Camera: Remidio Fundus on Phone (FOP) camera.
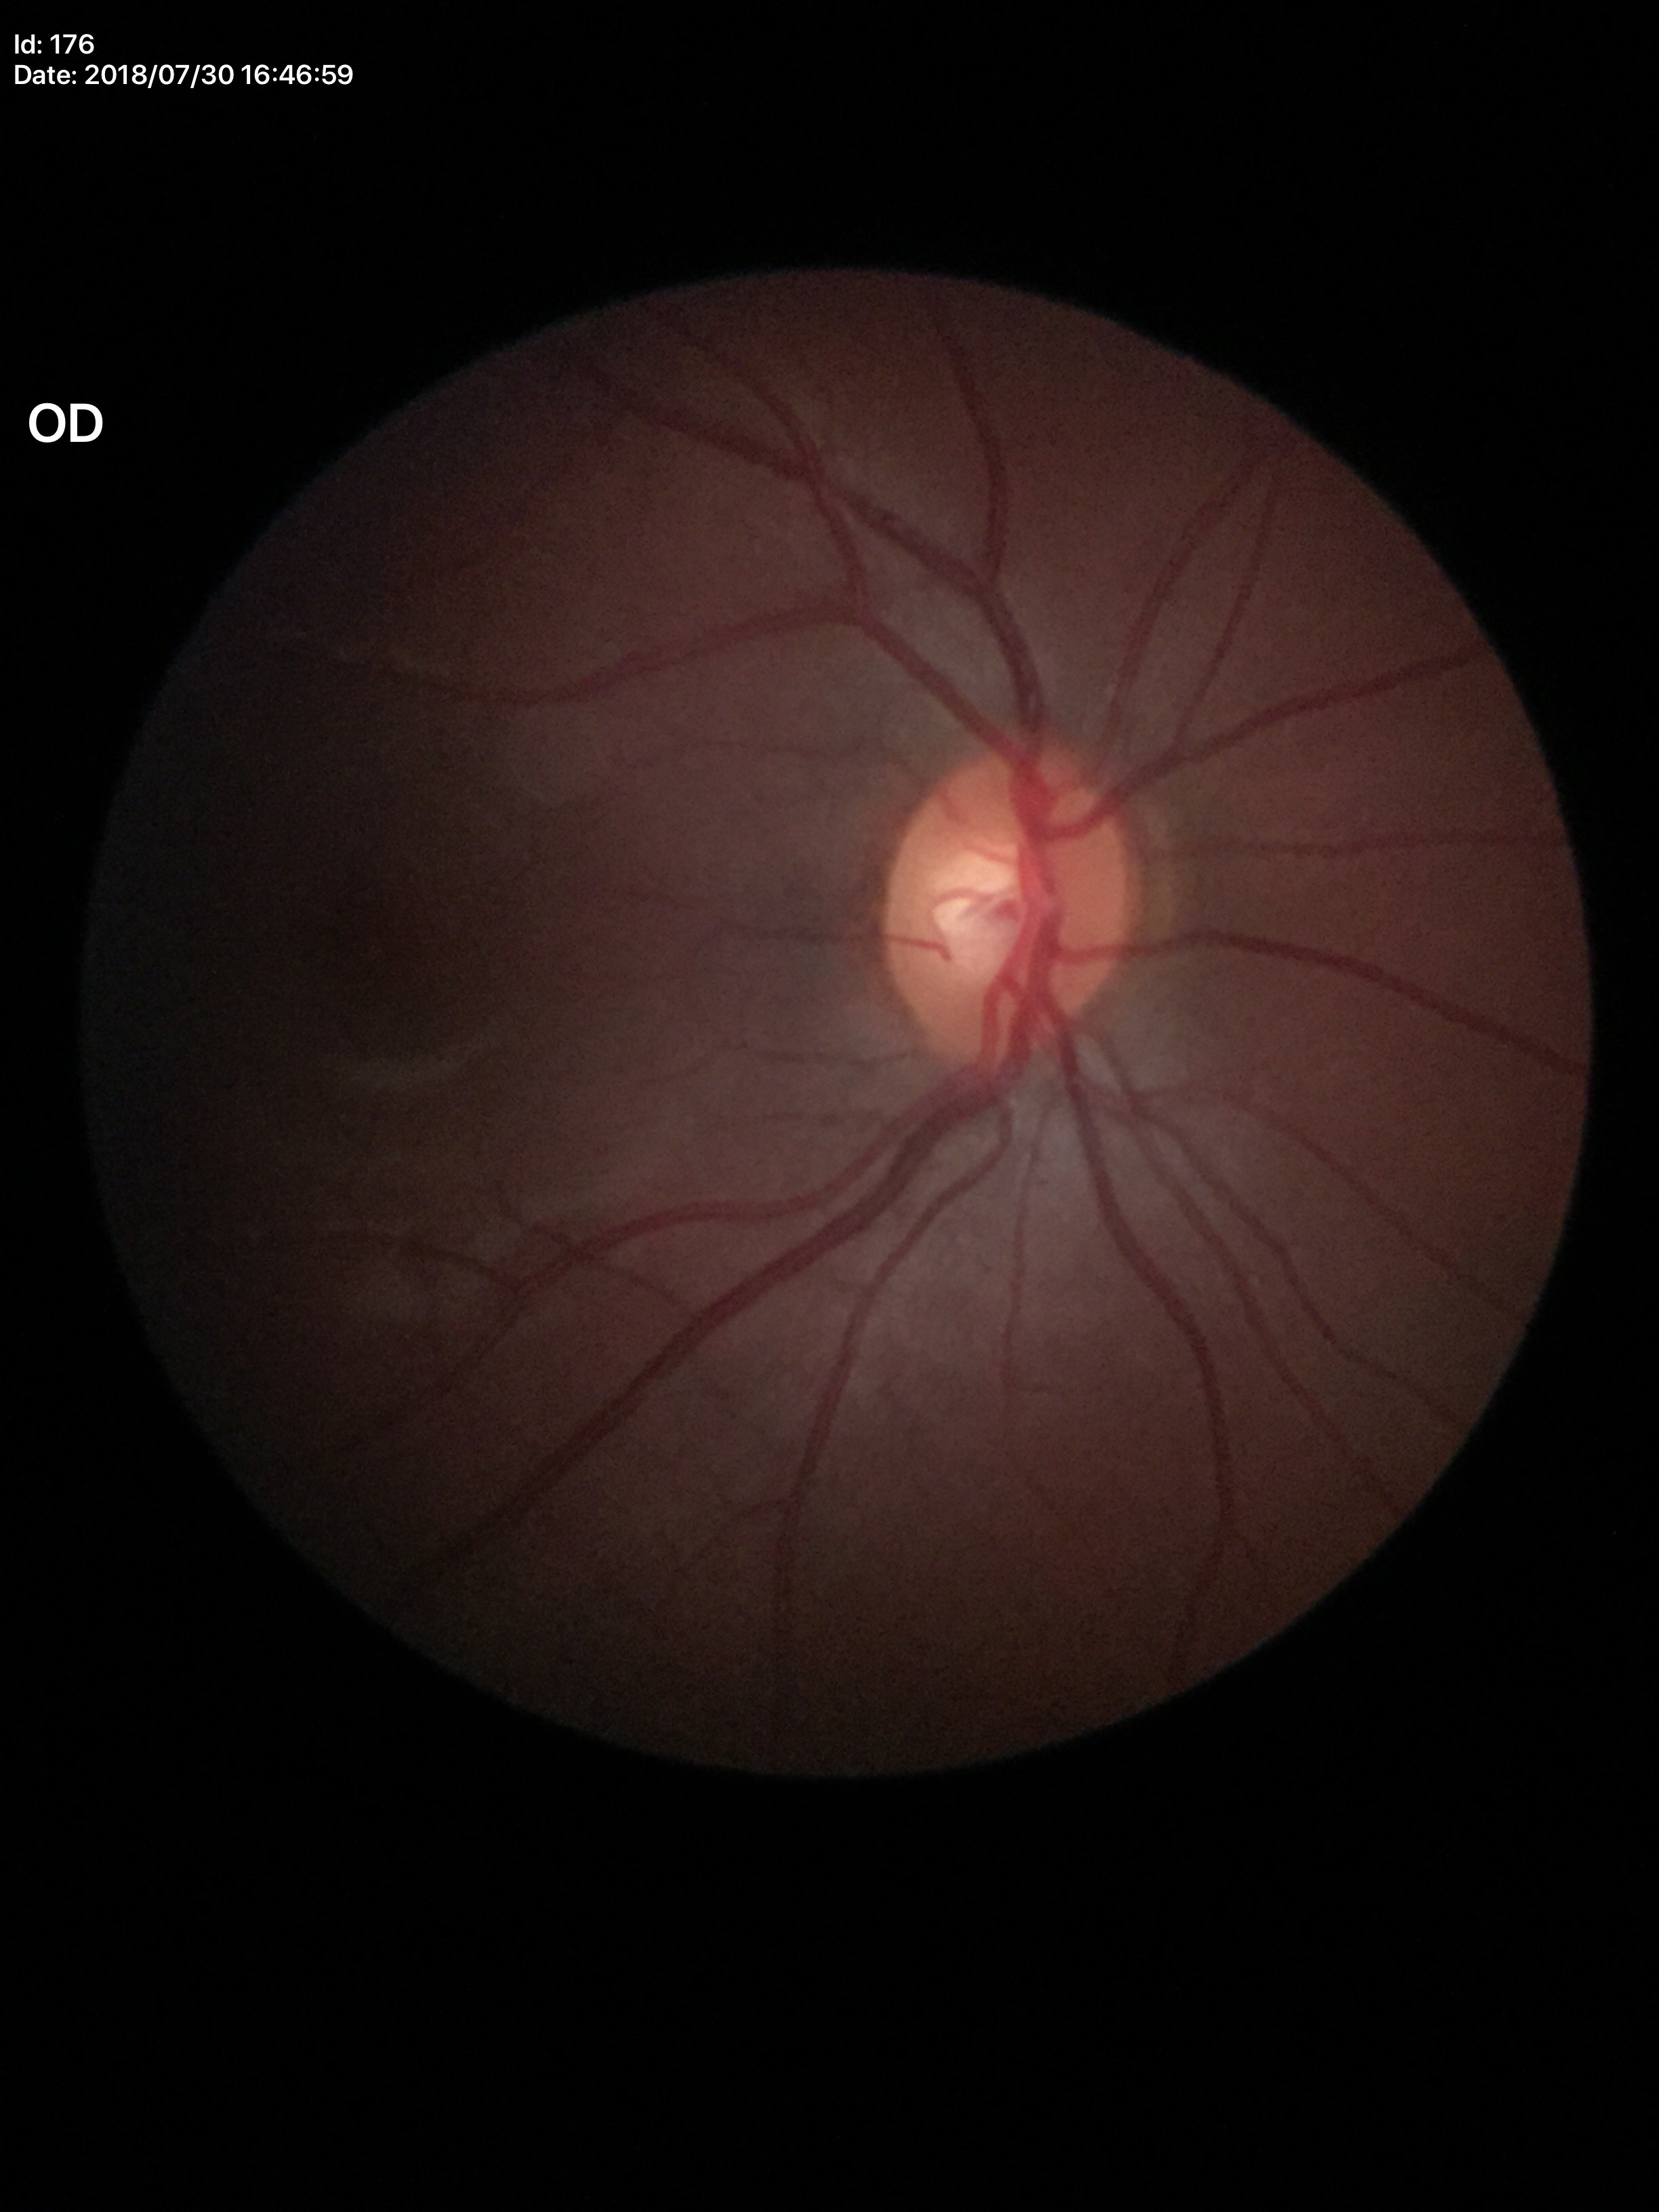
  glaucoma_decision: not suspect
  vcdr: 0.53
  hcdr: 0.54